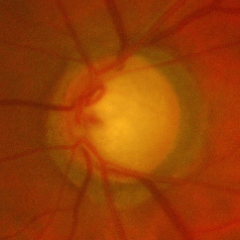

Advanced glaucomatous optic neuropathy.